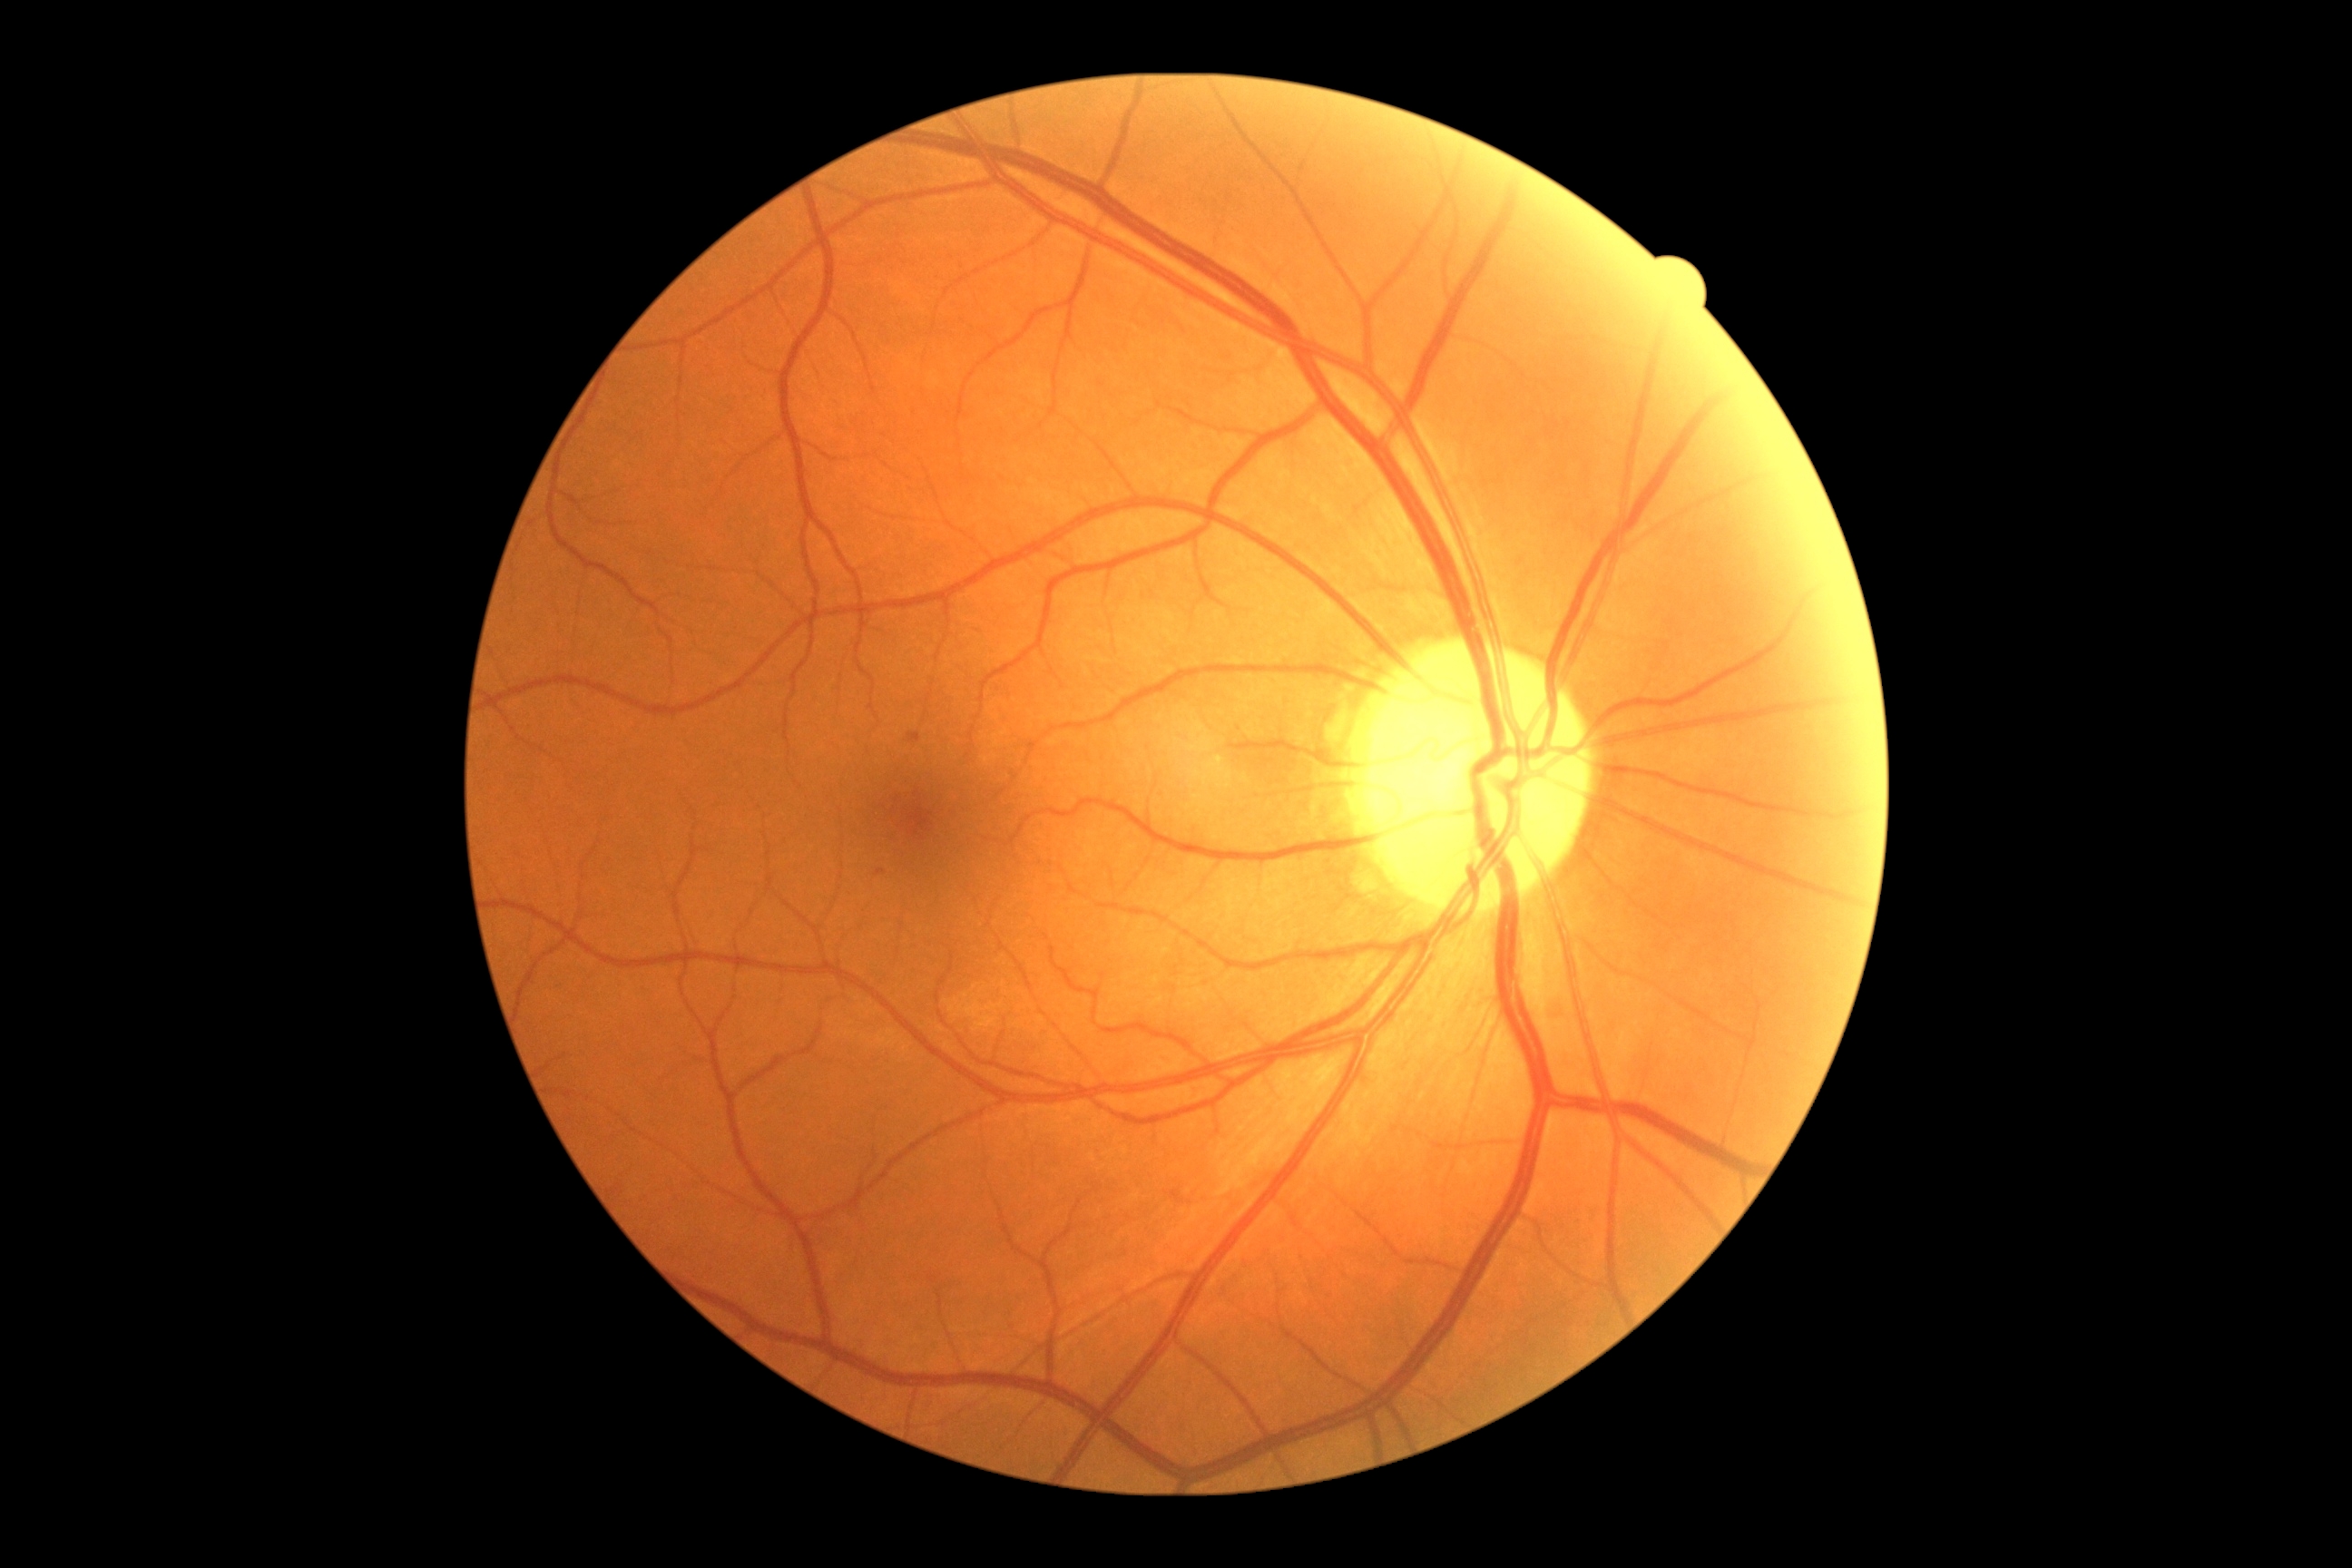 The retinopathy is classified as non-proliferative diabetic retinopathy. Diabetic retinopathy severity: grade 1.